848x848px · color fundus photograph · nonmydriatic fundus photograph
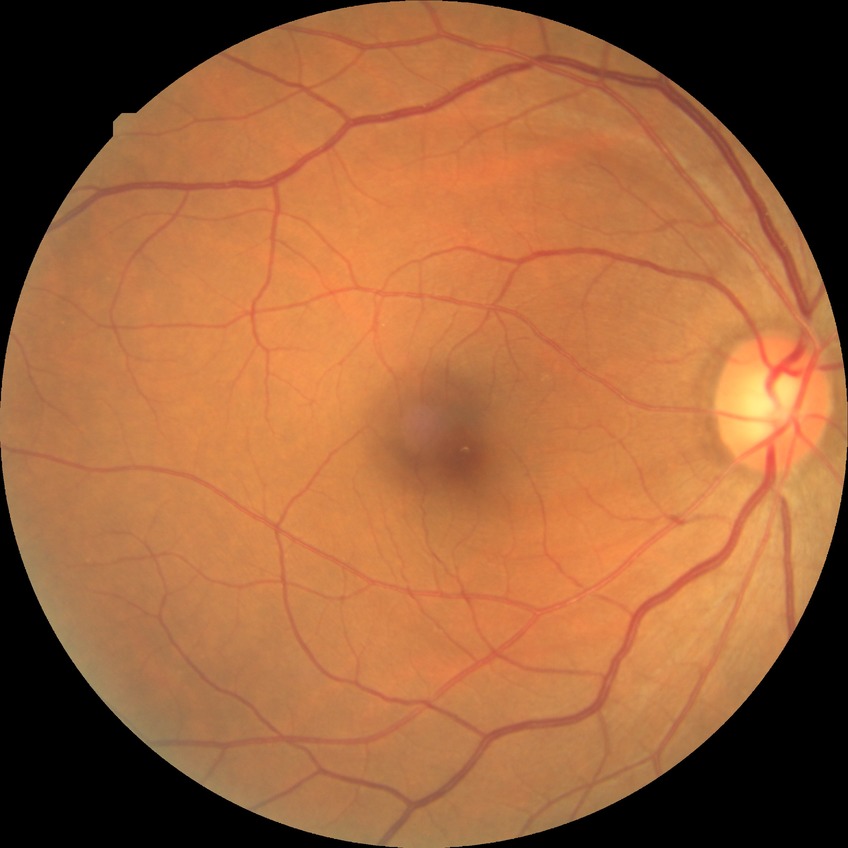

Diabetic retinopathy severity: simple diabetic retinopathy.